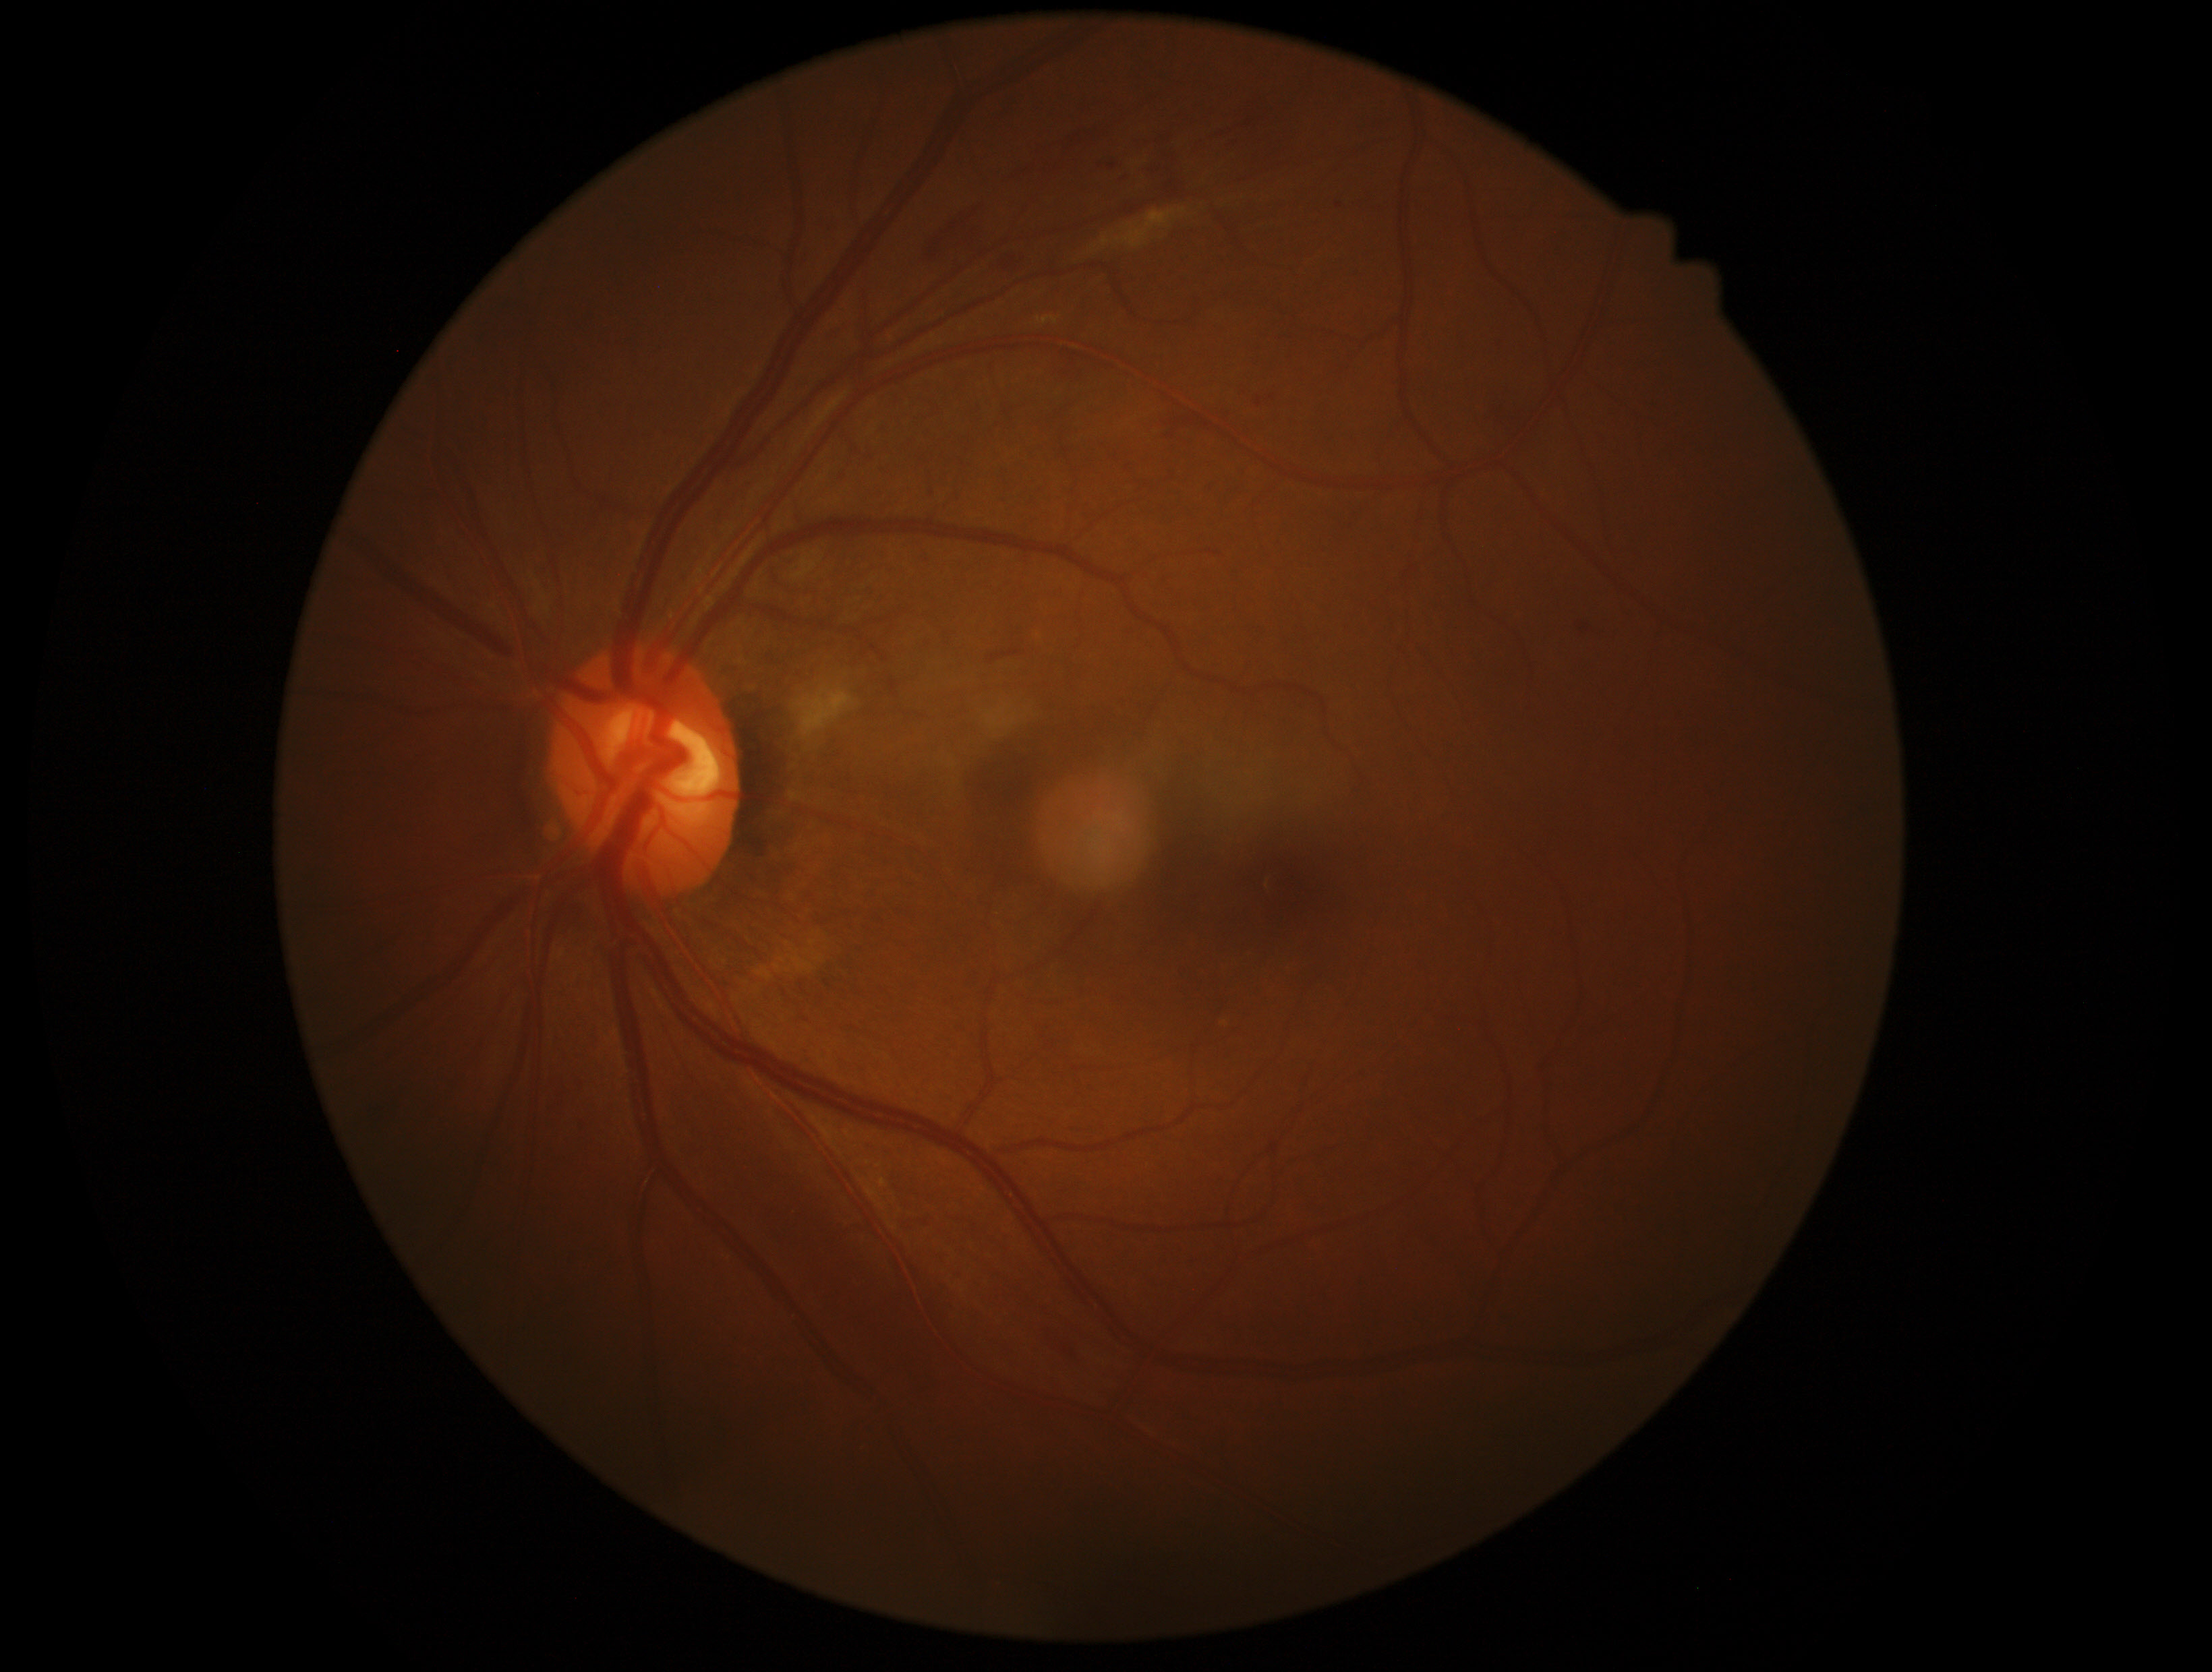
Diabetic retinopathy severity: 2.